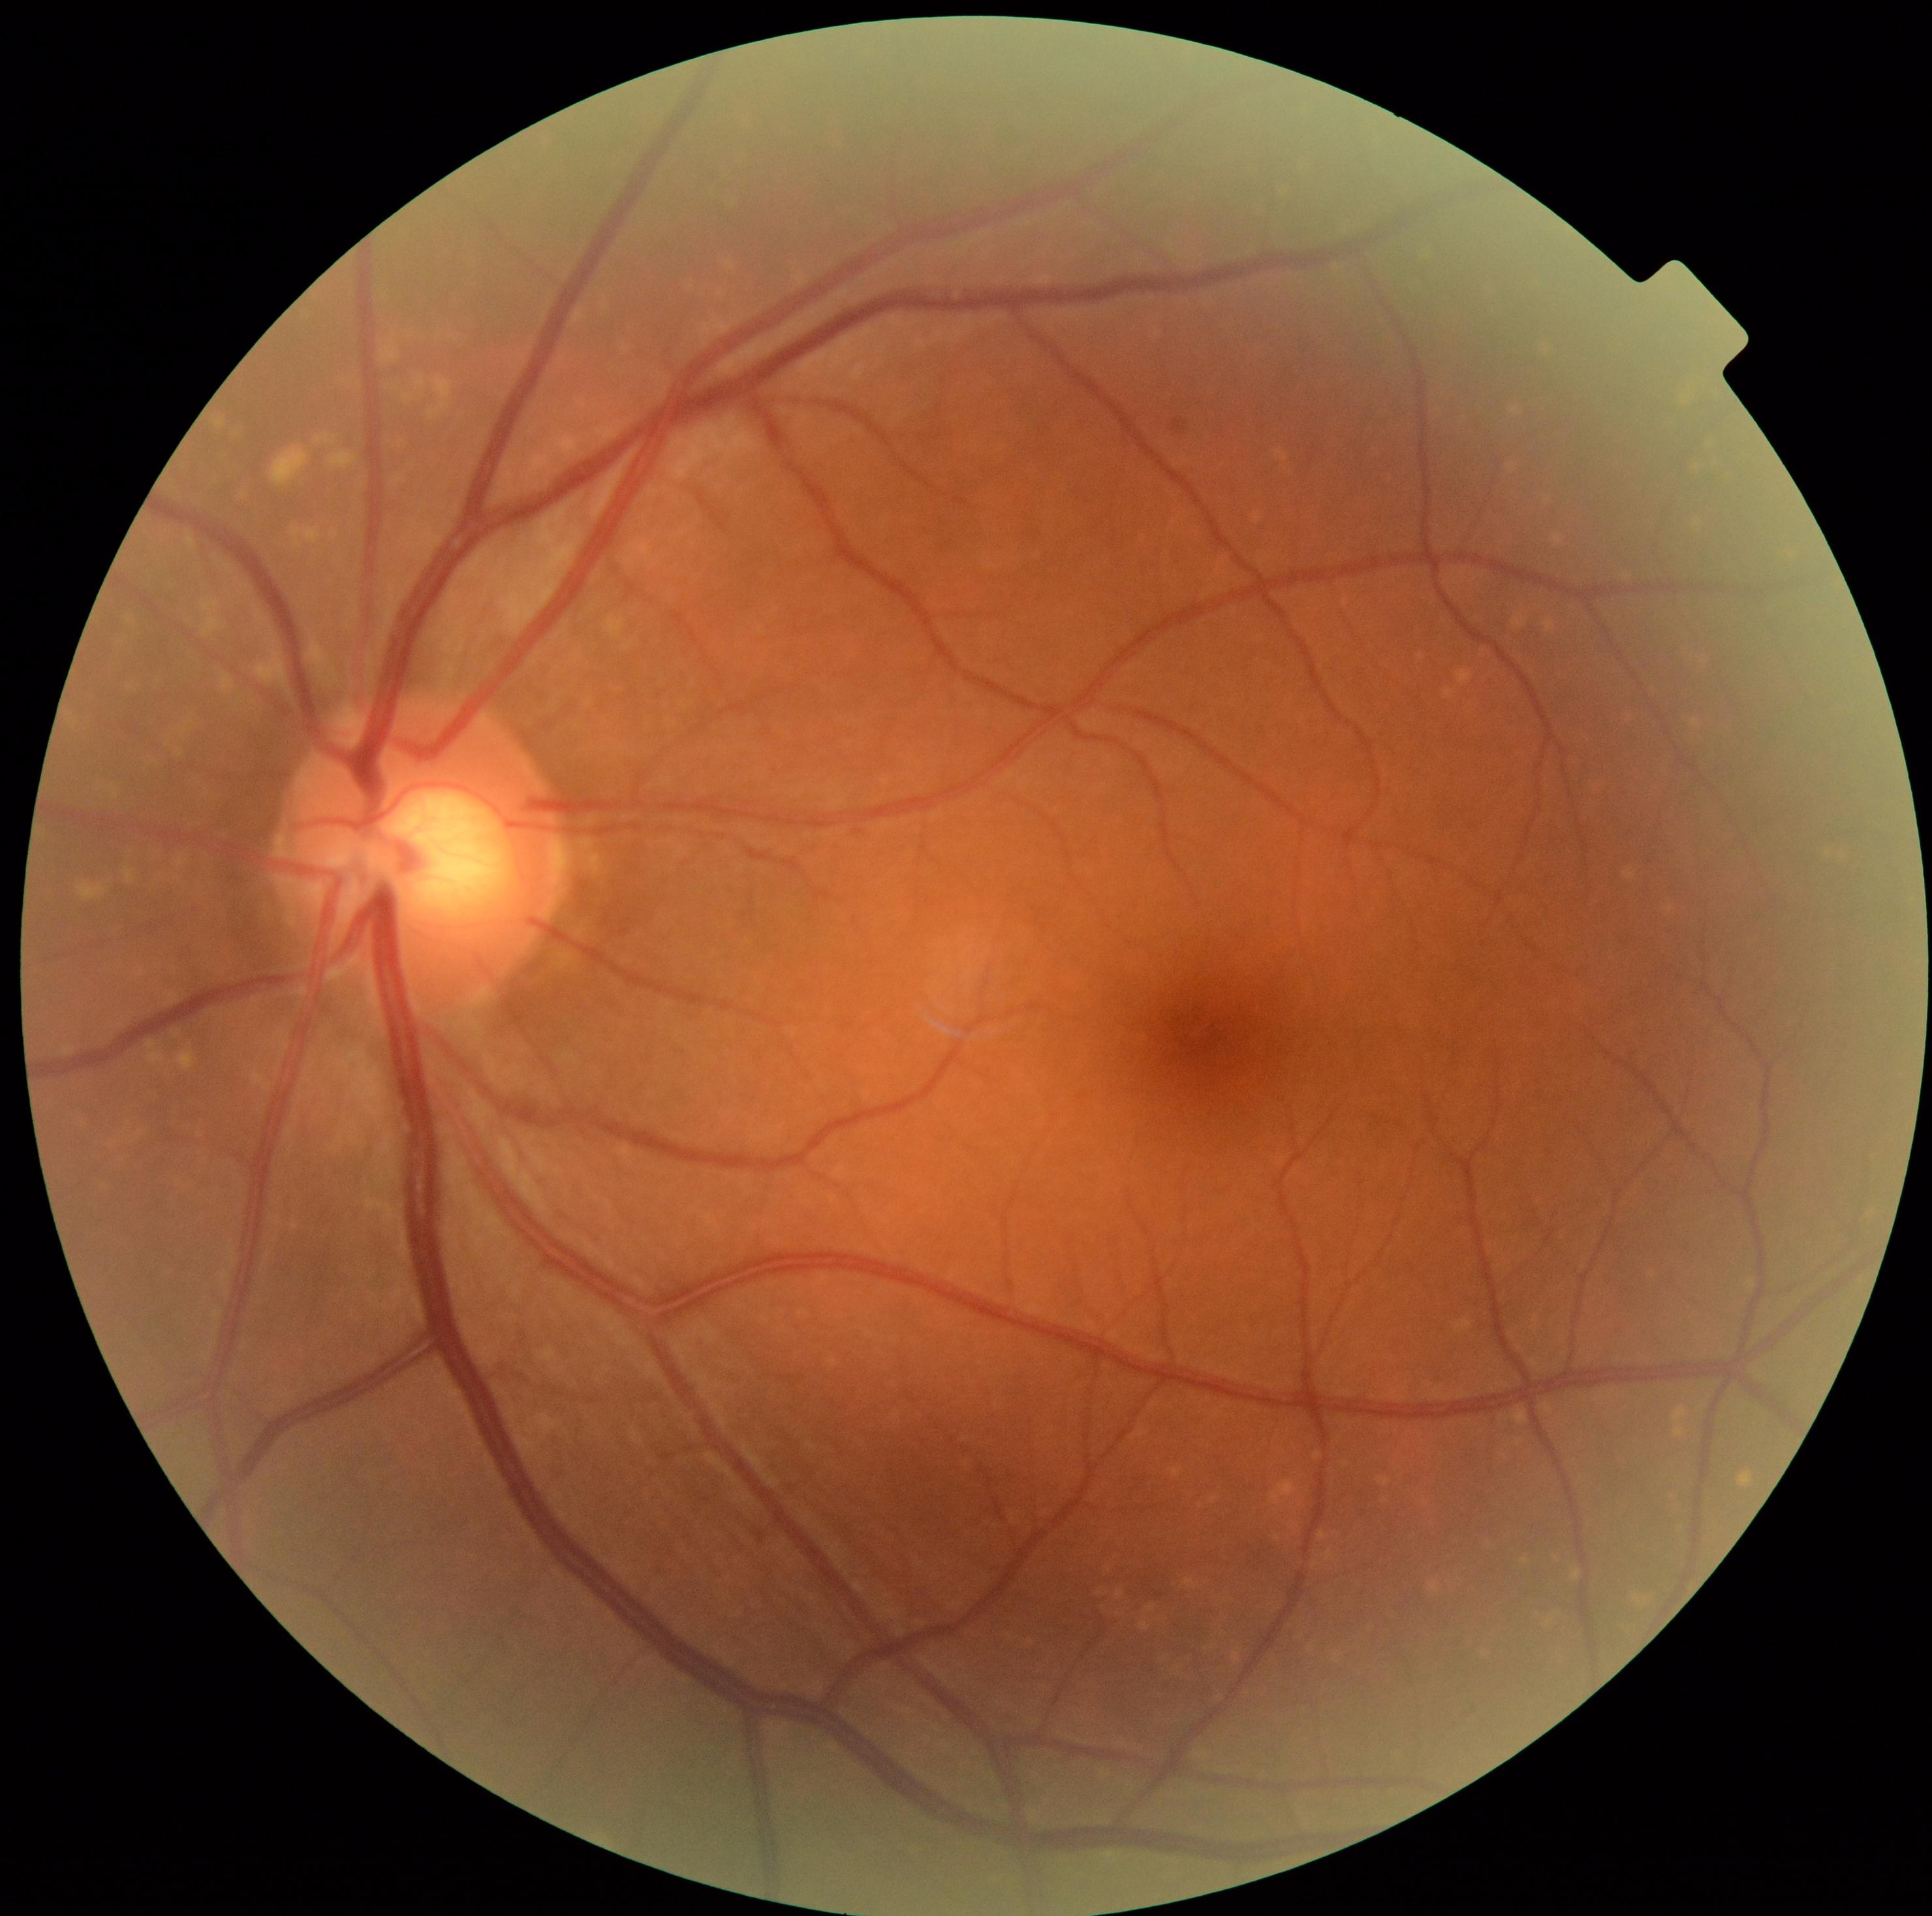 No DR findings. DR is 0/4.